DR severity per modified Davis staging; FOV: 45 degrees; 848 by 848 pixels.
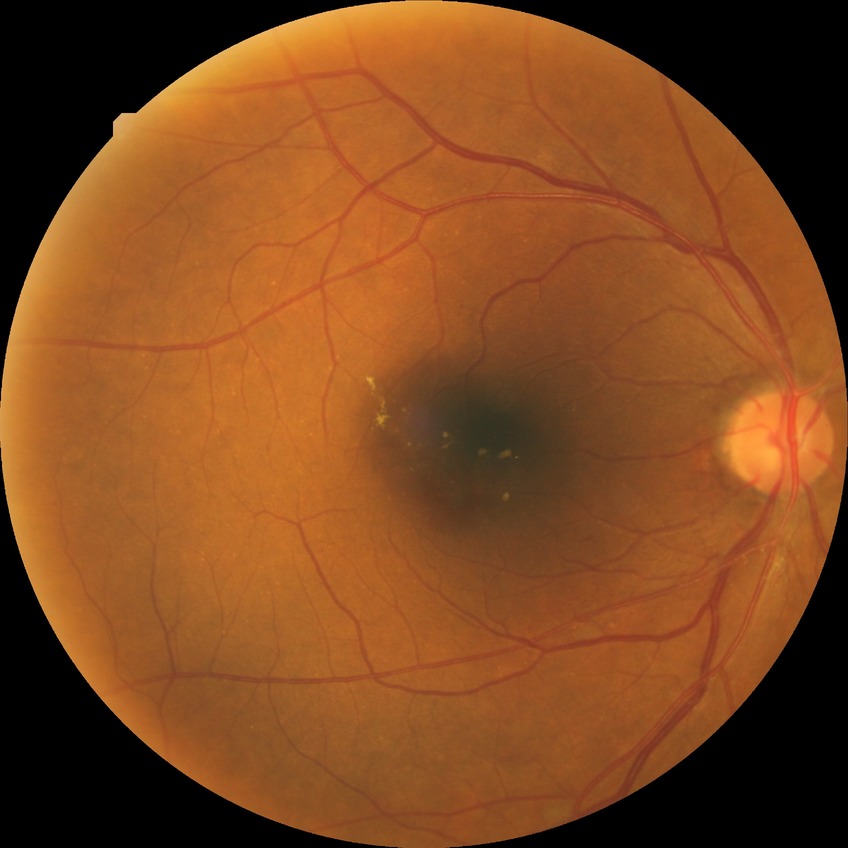
DR severity is SDR. The retinopathy is classified as non-proliferative diabetic retinopathy.